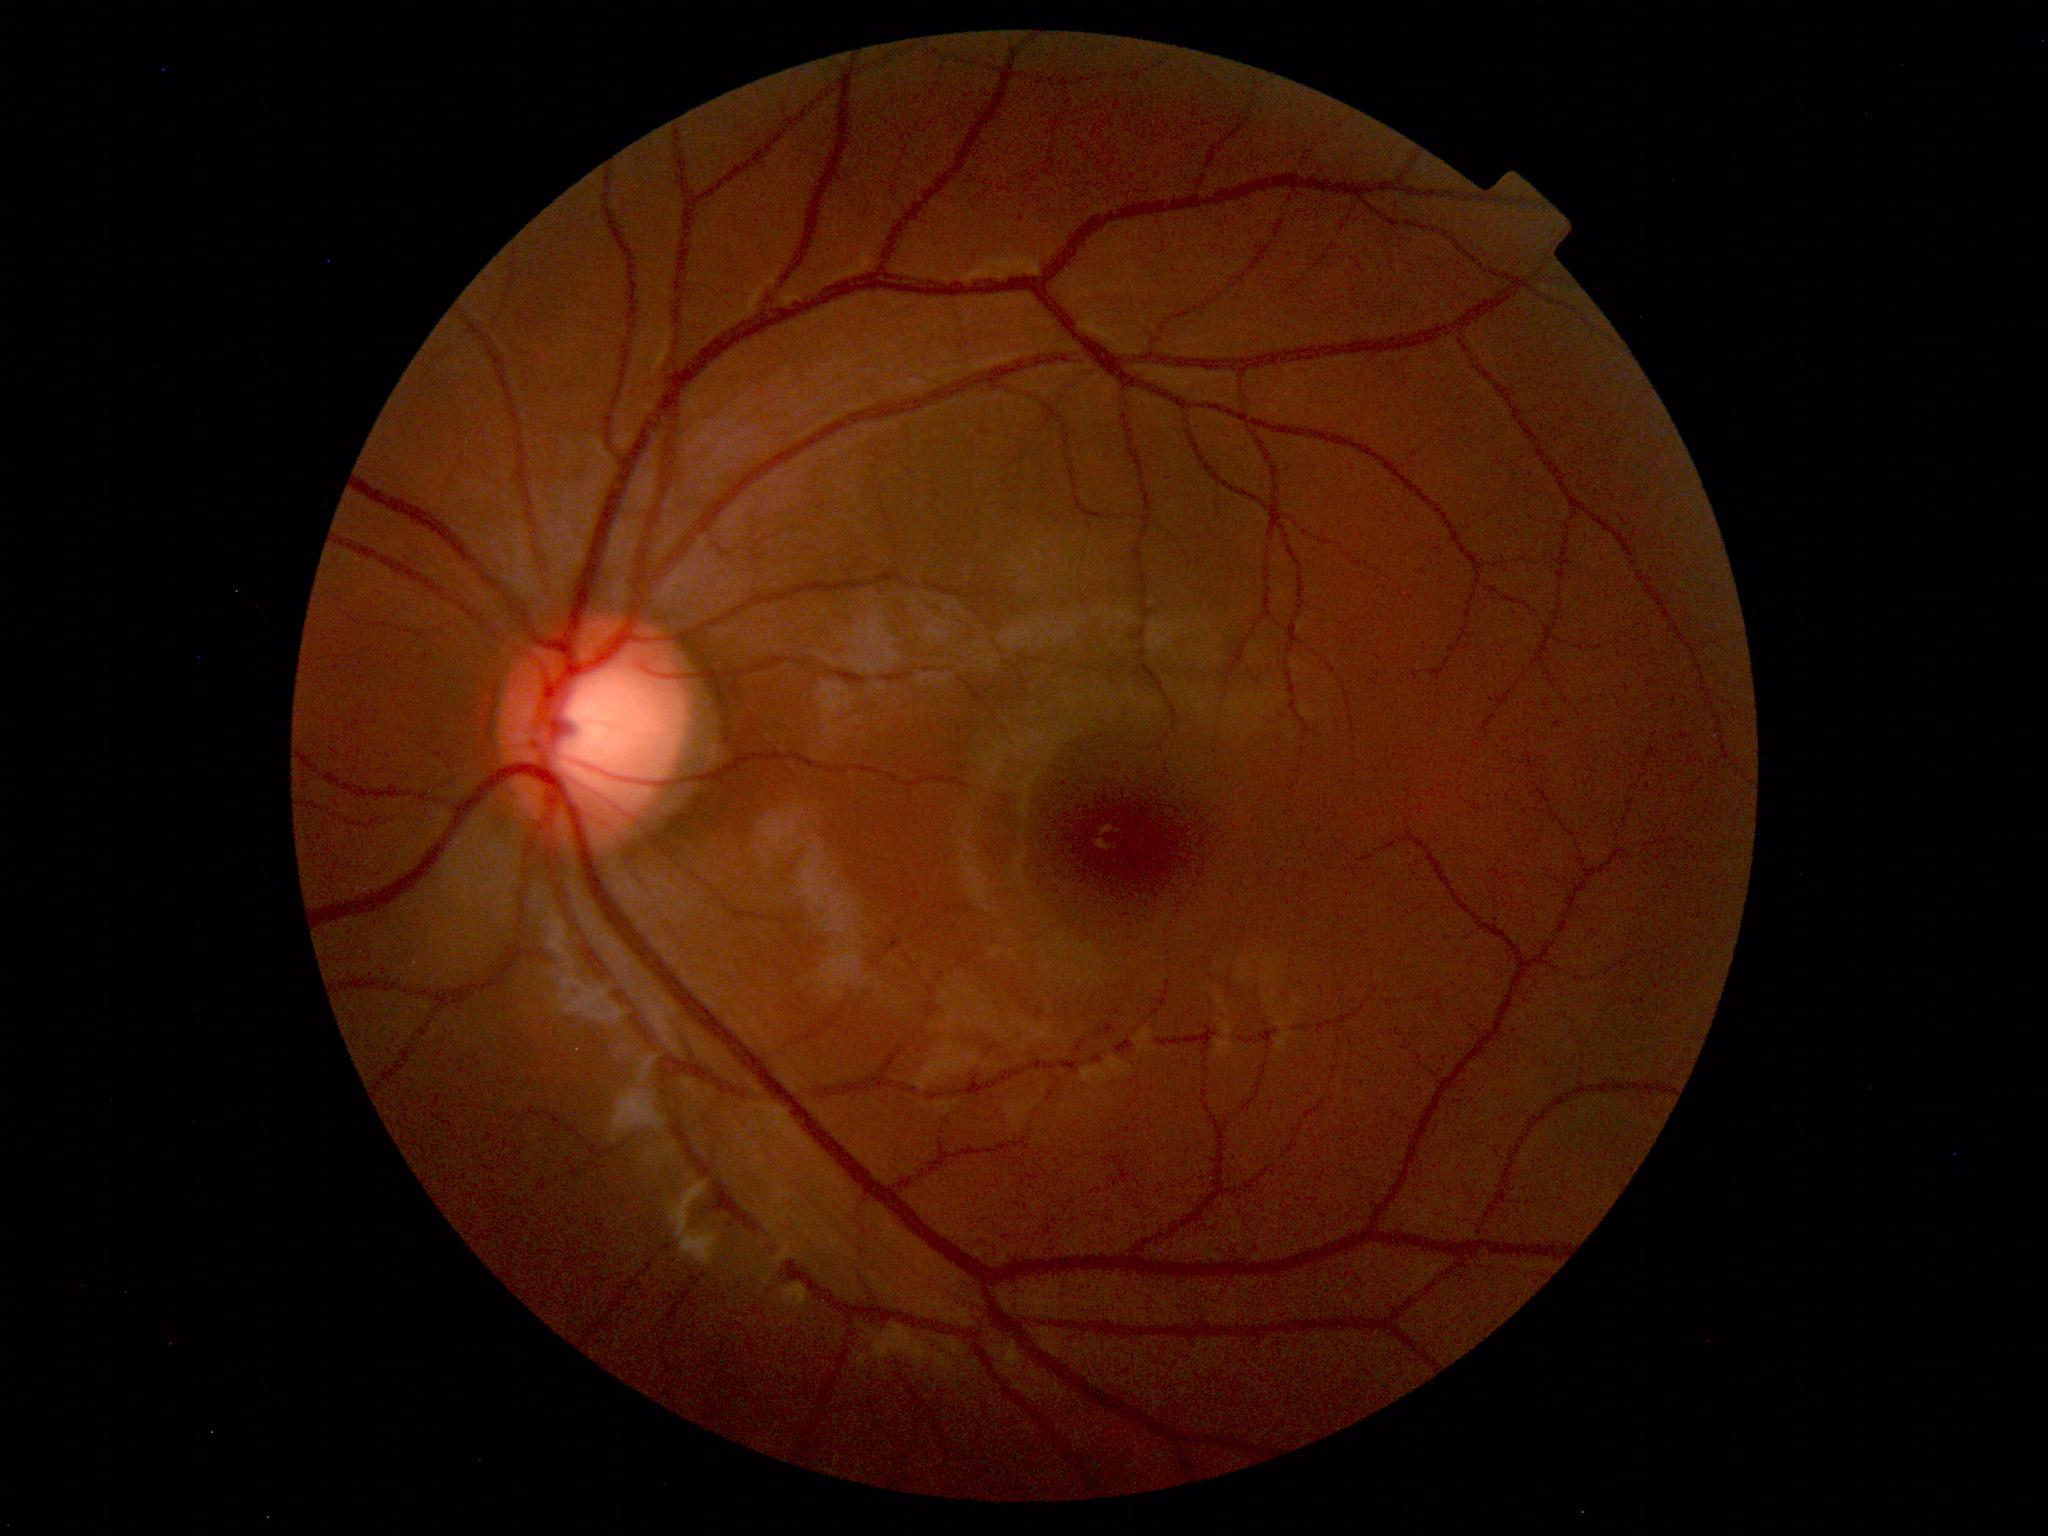 No abnormal findings on fundus examination.